DR severity per modified Davis staging:
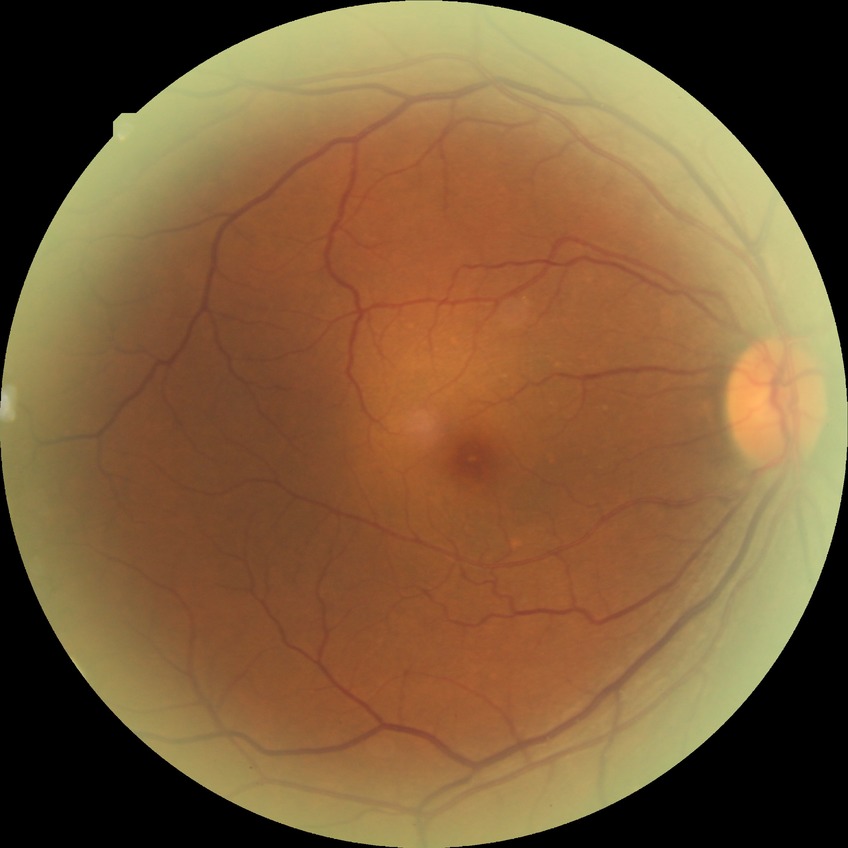
Diabetic retinopathy (DR) is no diabetic retinopathy (NDR).